Acquired on the Phoenix ICON · Phoenix ICON wide-field infant fundus image.
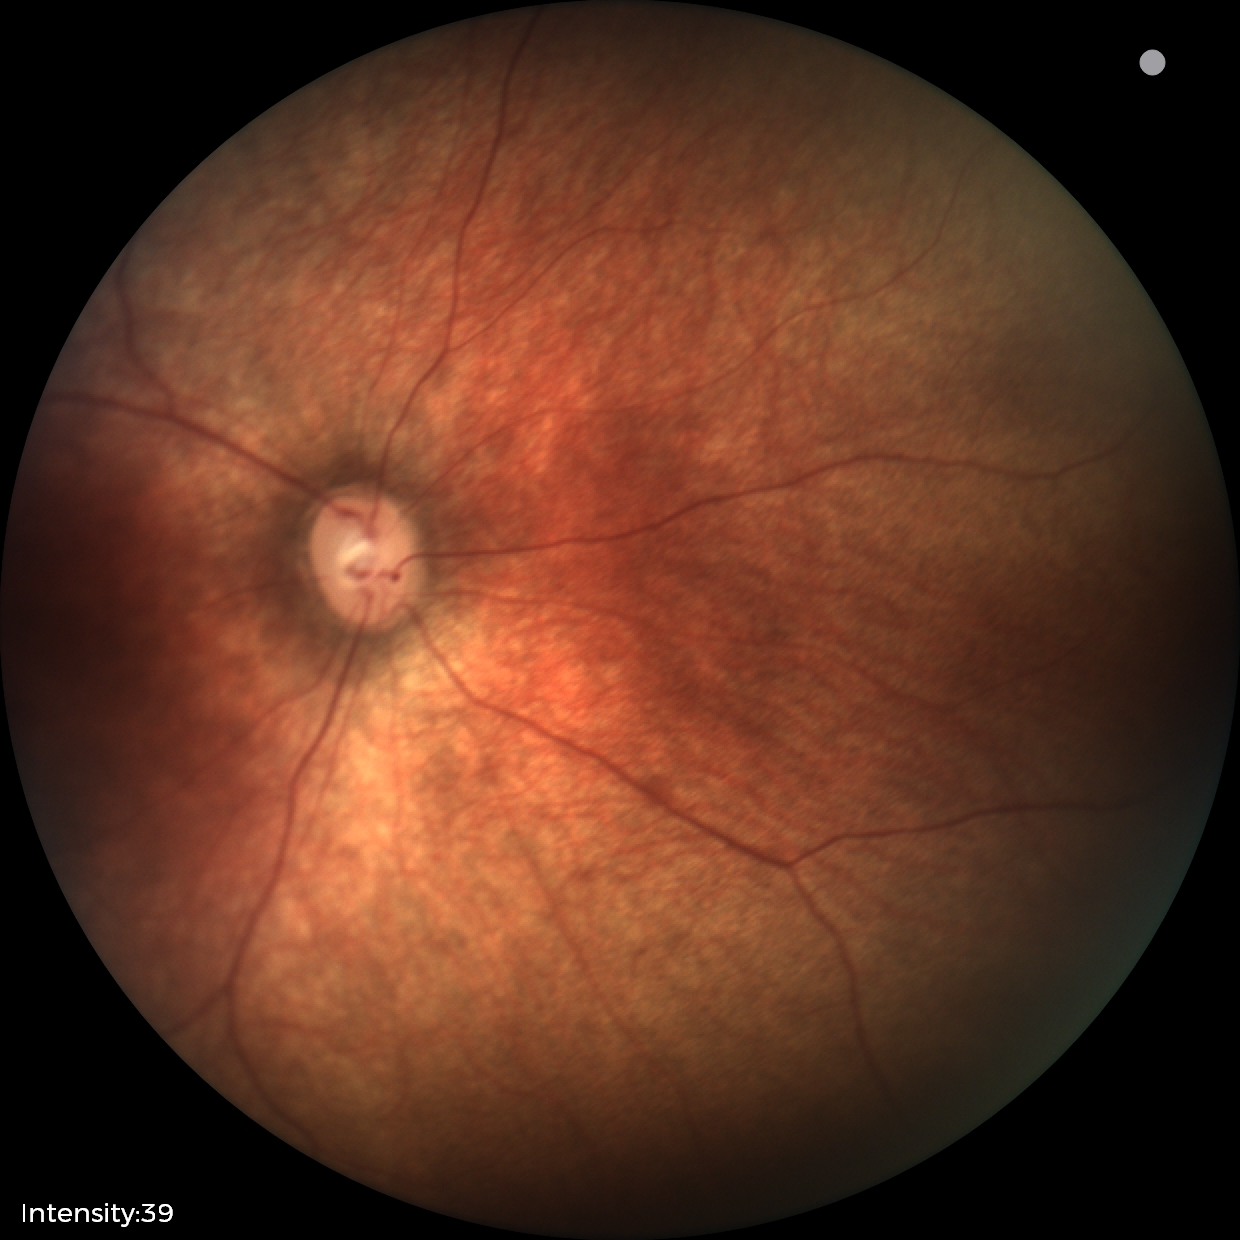
Screening diagnosis: no abnormal retinal findings.